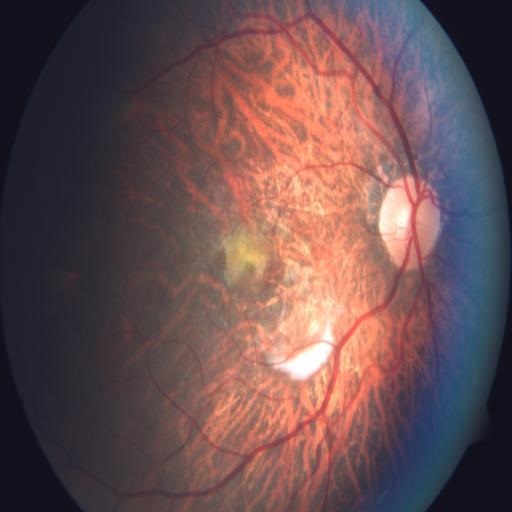 Pathology: macular scar (MS), myopia (MYA), tessellation (TSLN).